Phoenix ICON, 100° FOV; infant wide-field retinal image.
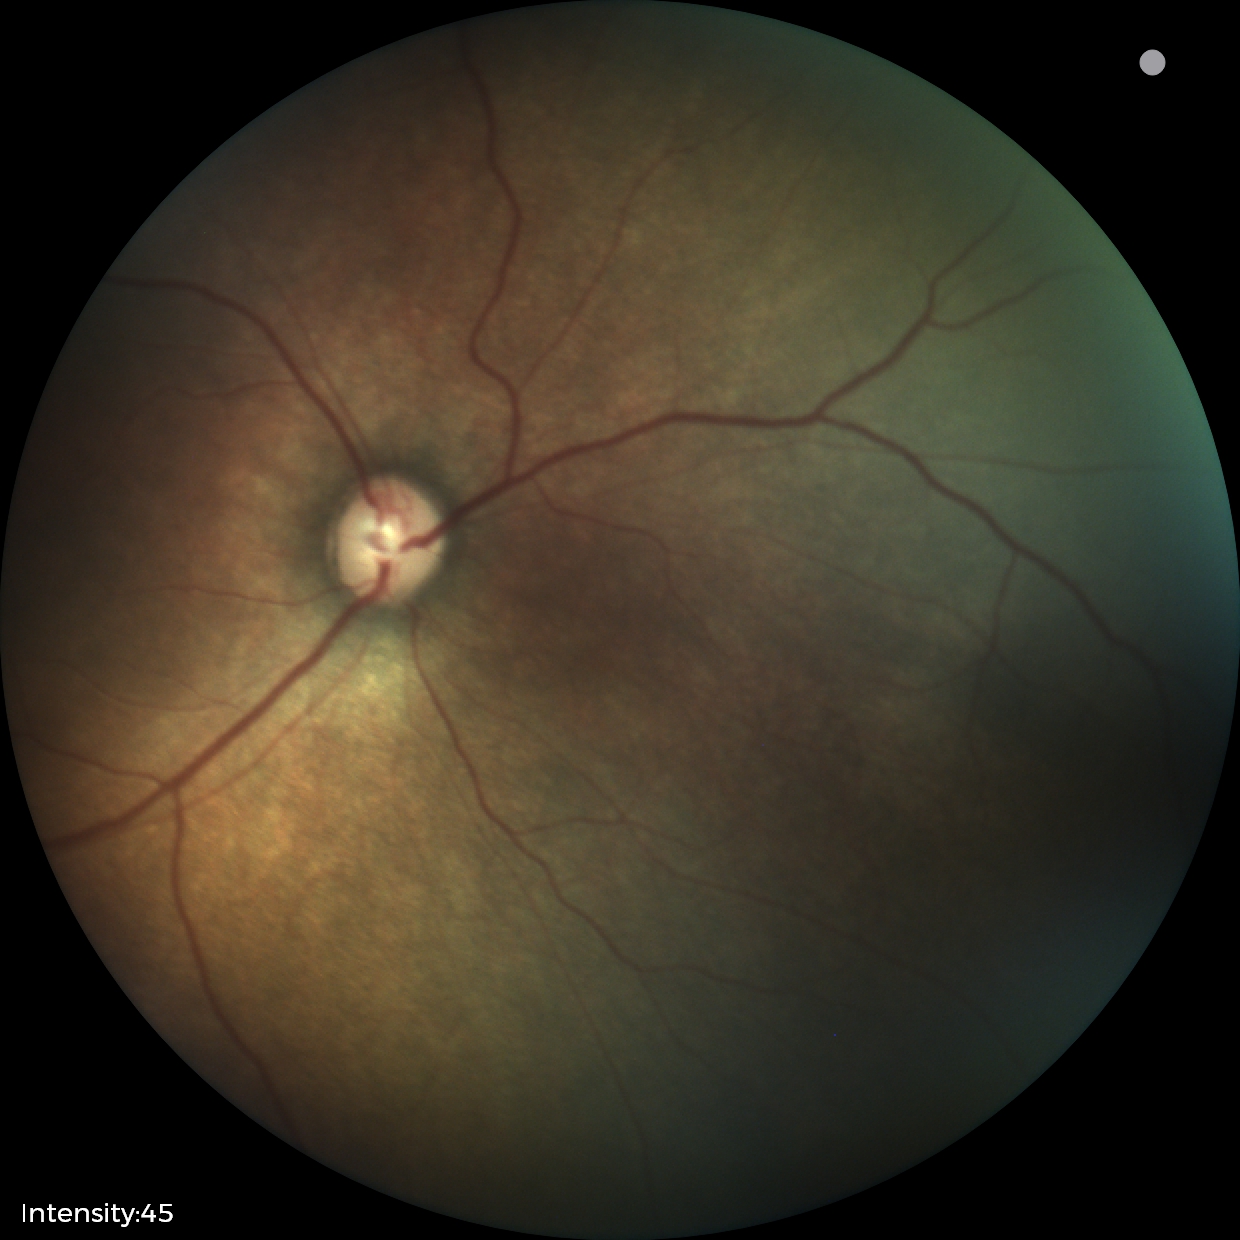
Screening series with status post retinopathy of prematurity. Without plus disease.